Fundus photo
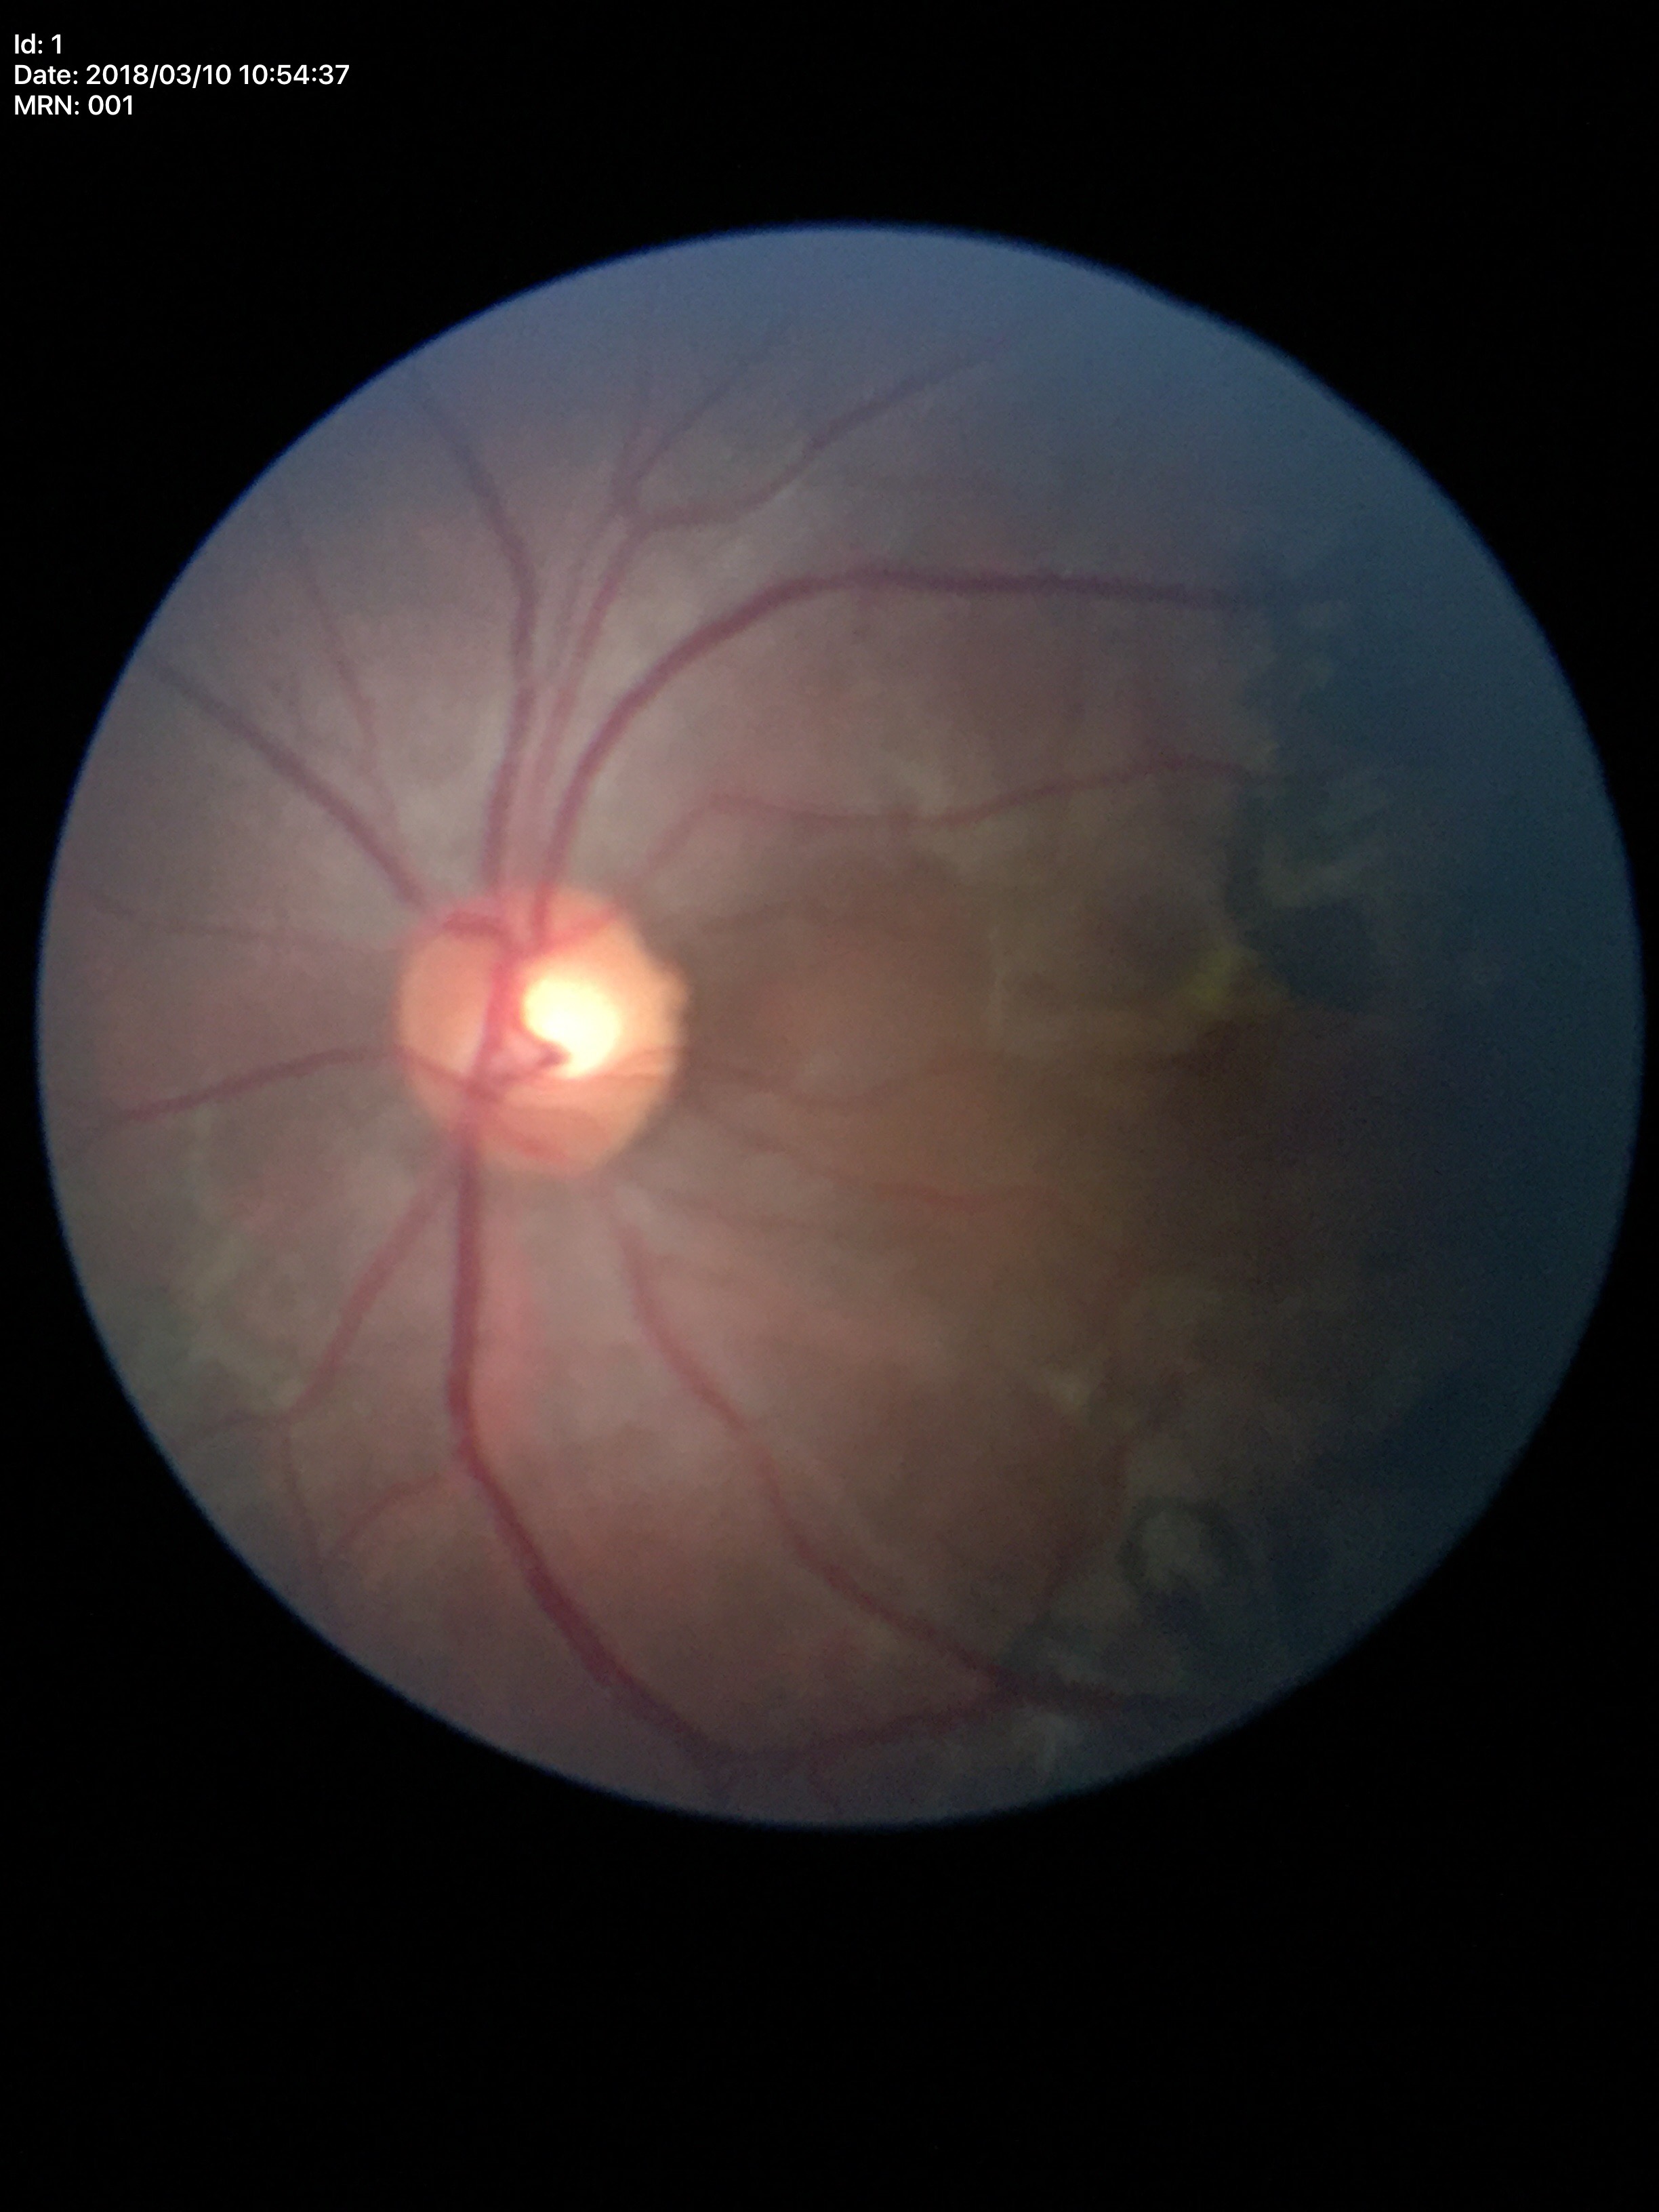

{
  "vcdr": "0.48",
  "glaucoma_decision": "not suspect"
}